Color fundus photograph: 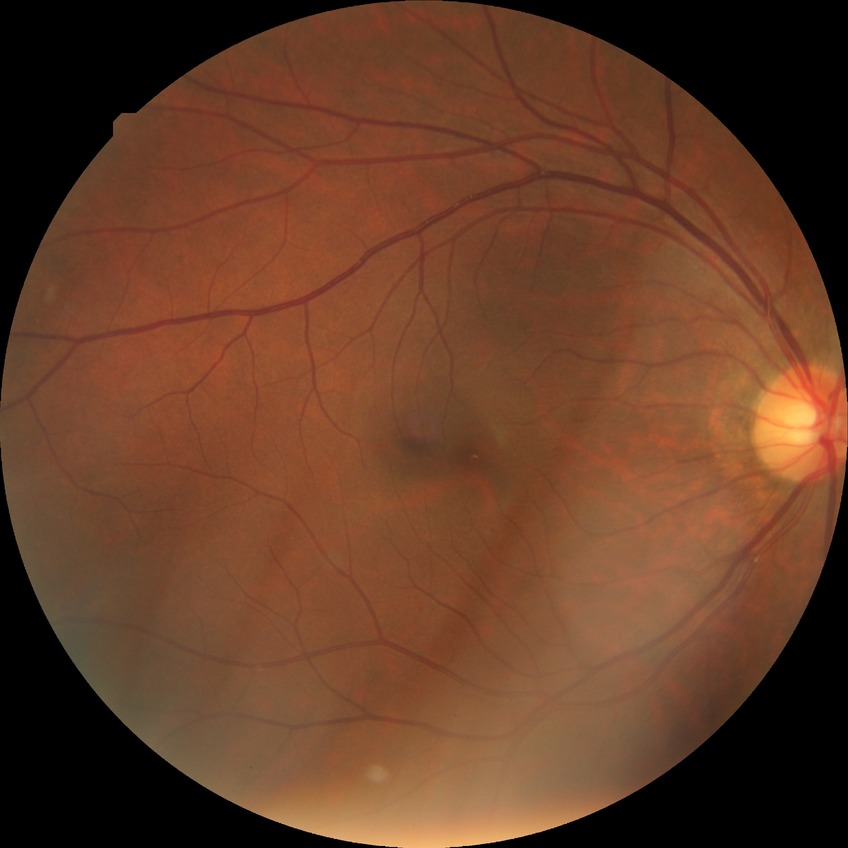 diabetic retinopathy grade: no diabetic retinopathy.